Graded on the modified Davis scale: 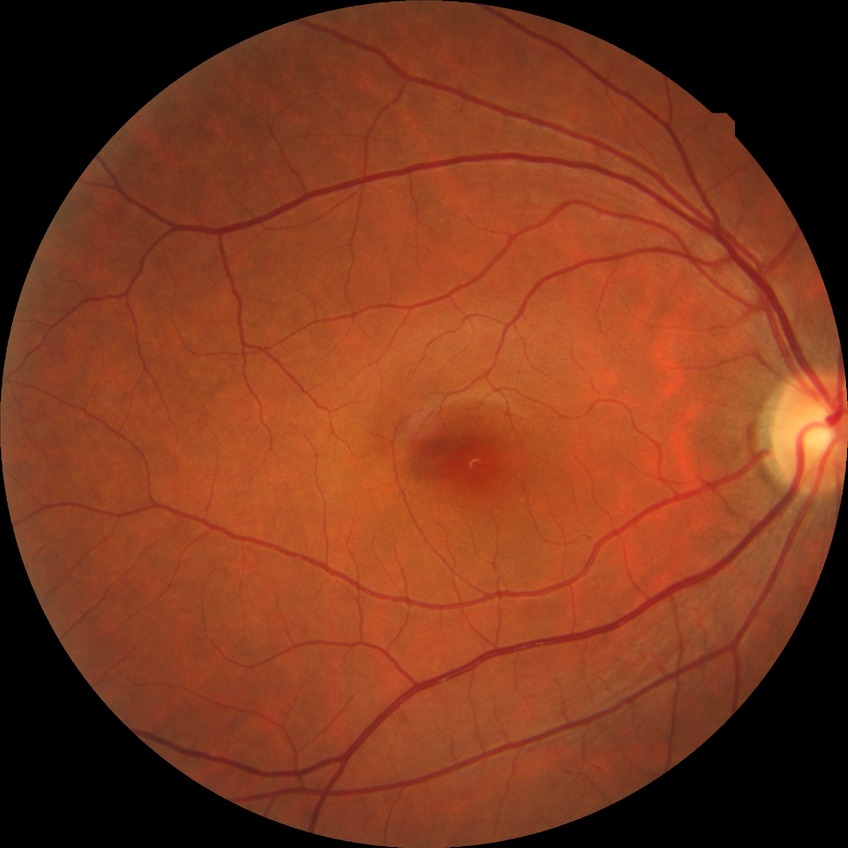

* diabetic retinopathy (DR) — NDR (no diabetic retinopathy)